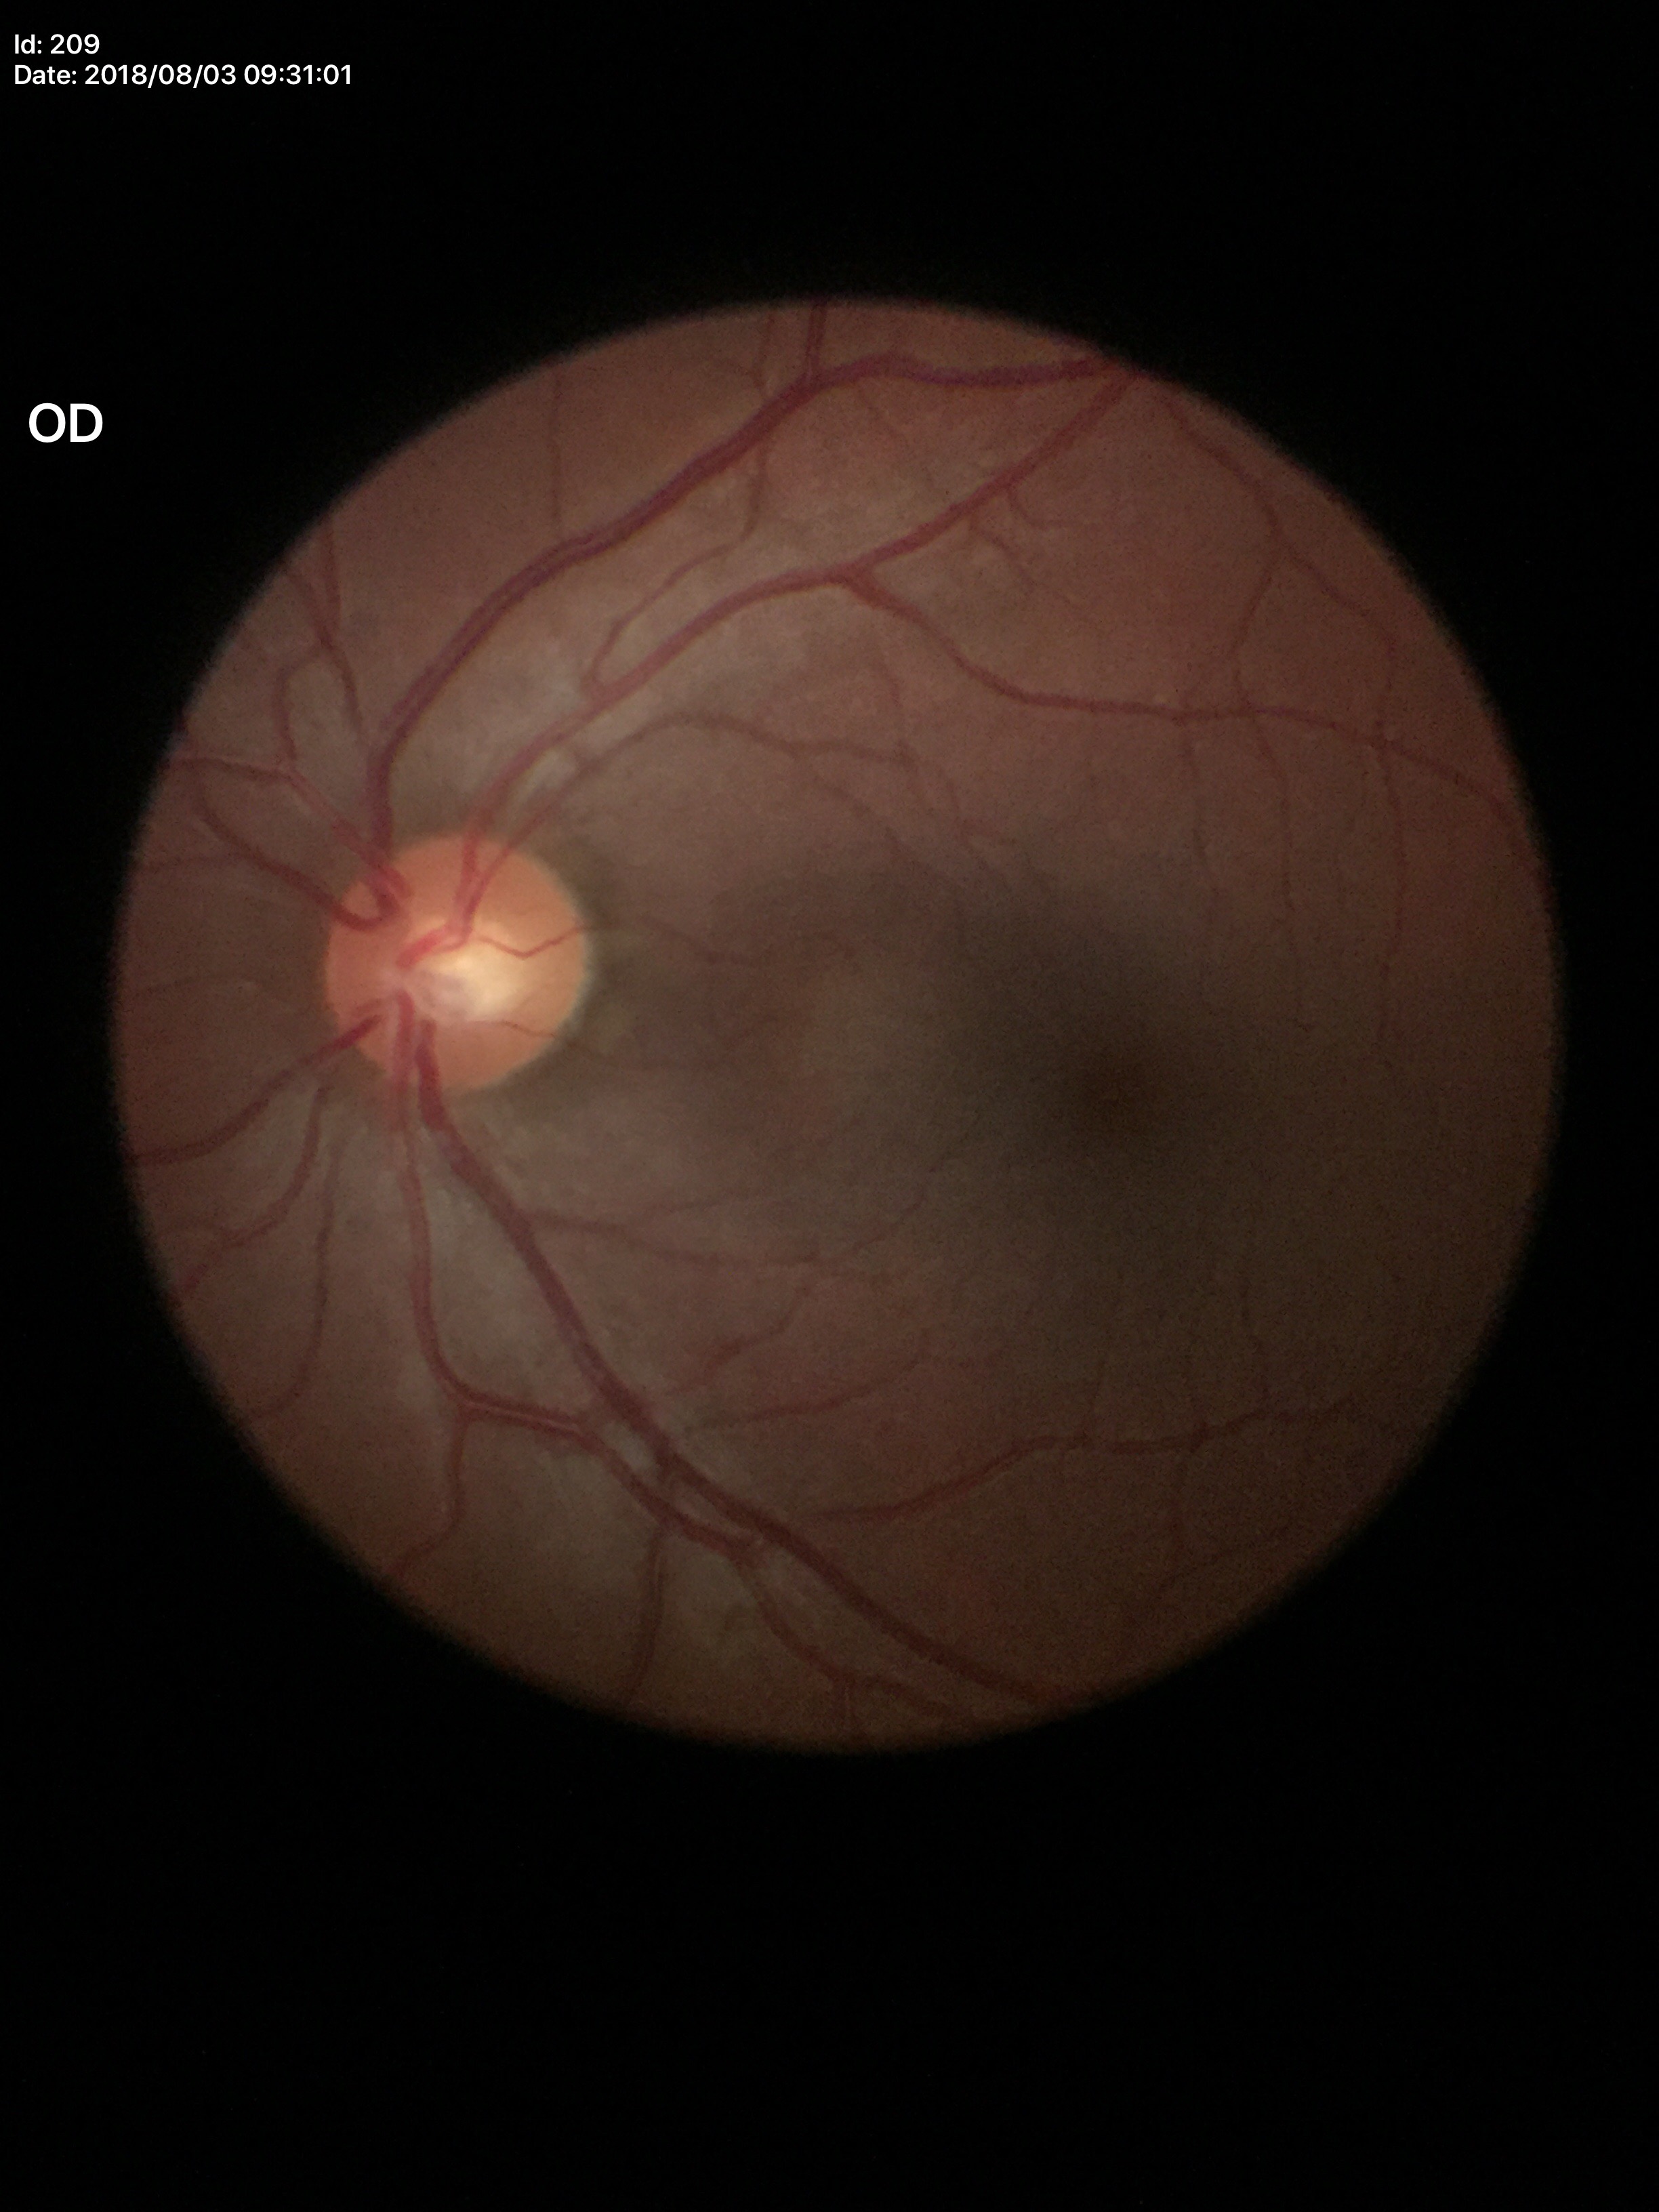

Horizontal cup-to-disc ratio of 0.49. Vertical cup-to-disc ratio is 0.44. No glaucomatous optic neuropathy (unanimous normal call). Area cup-disc ratio is 0.22.